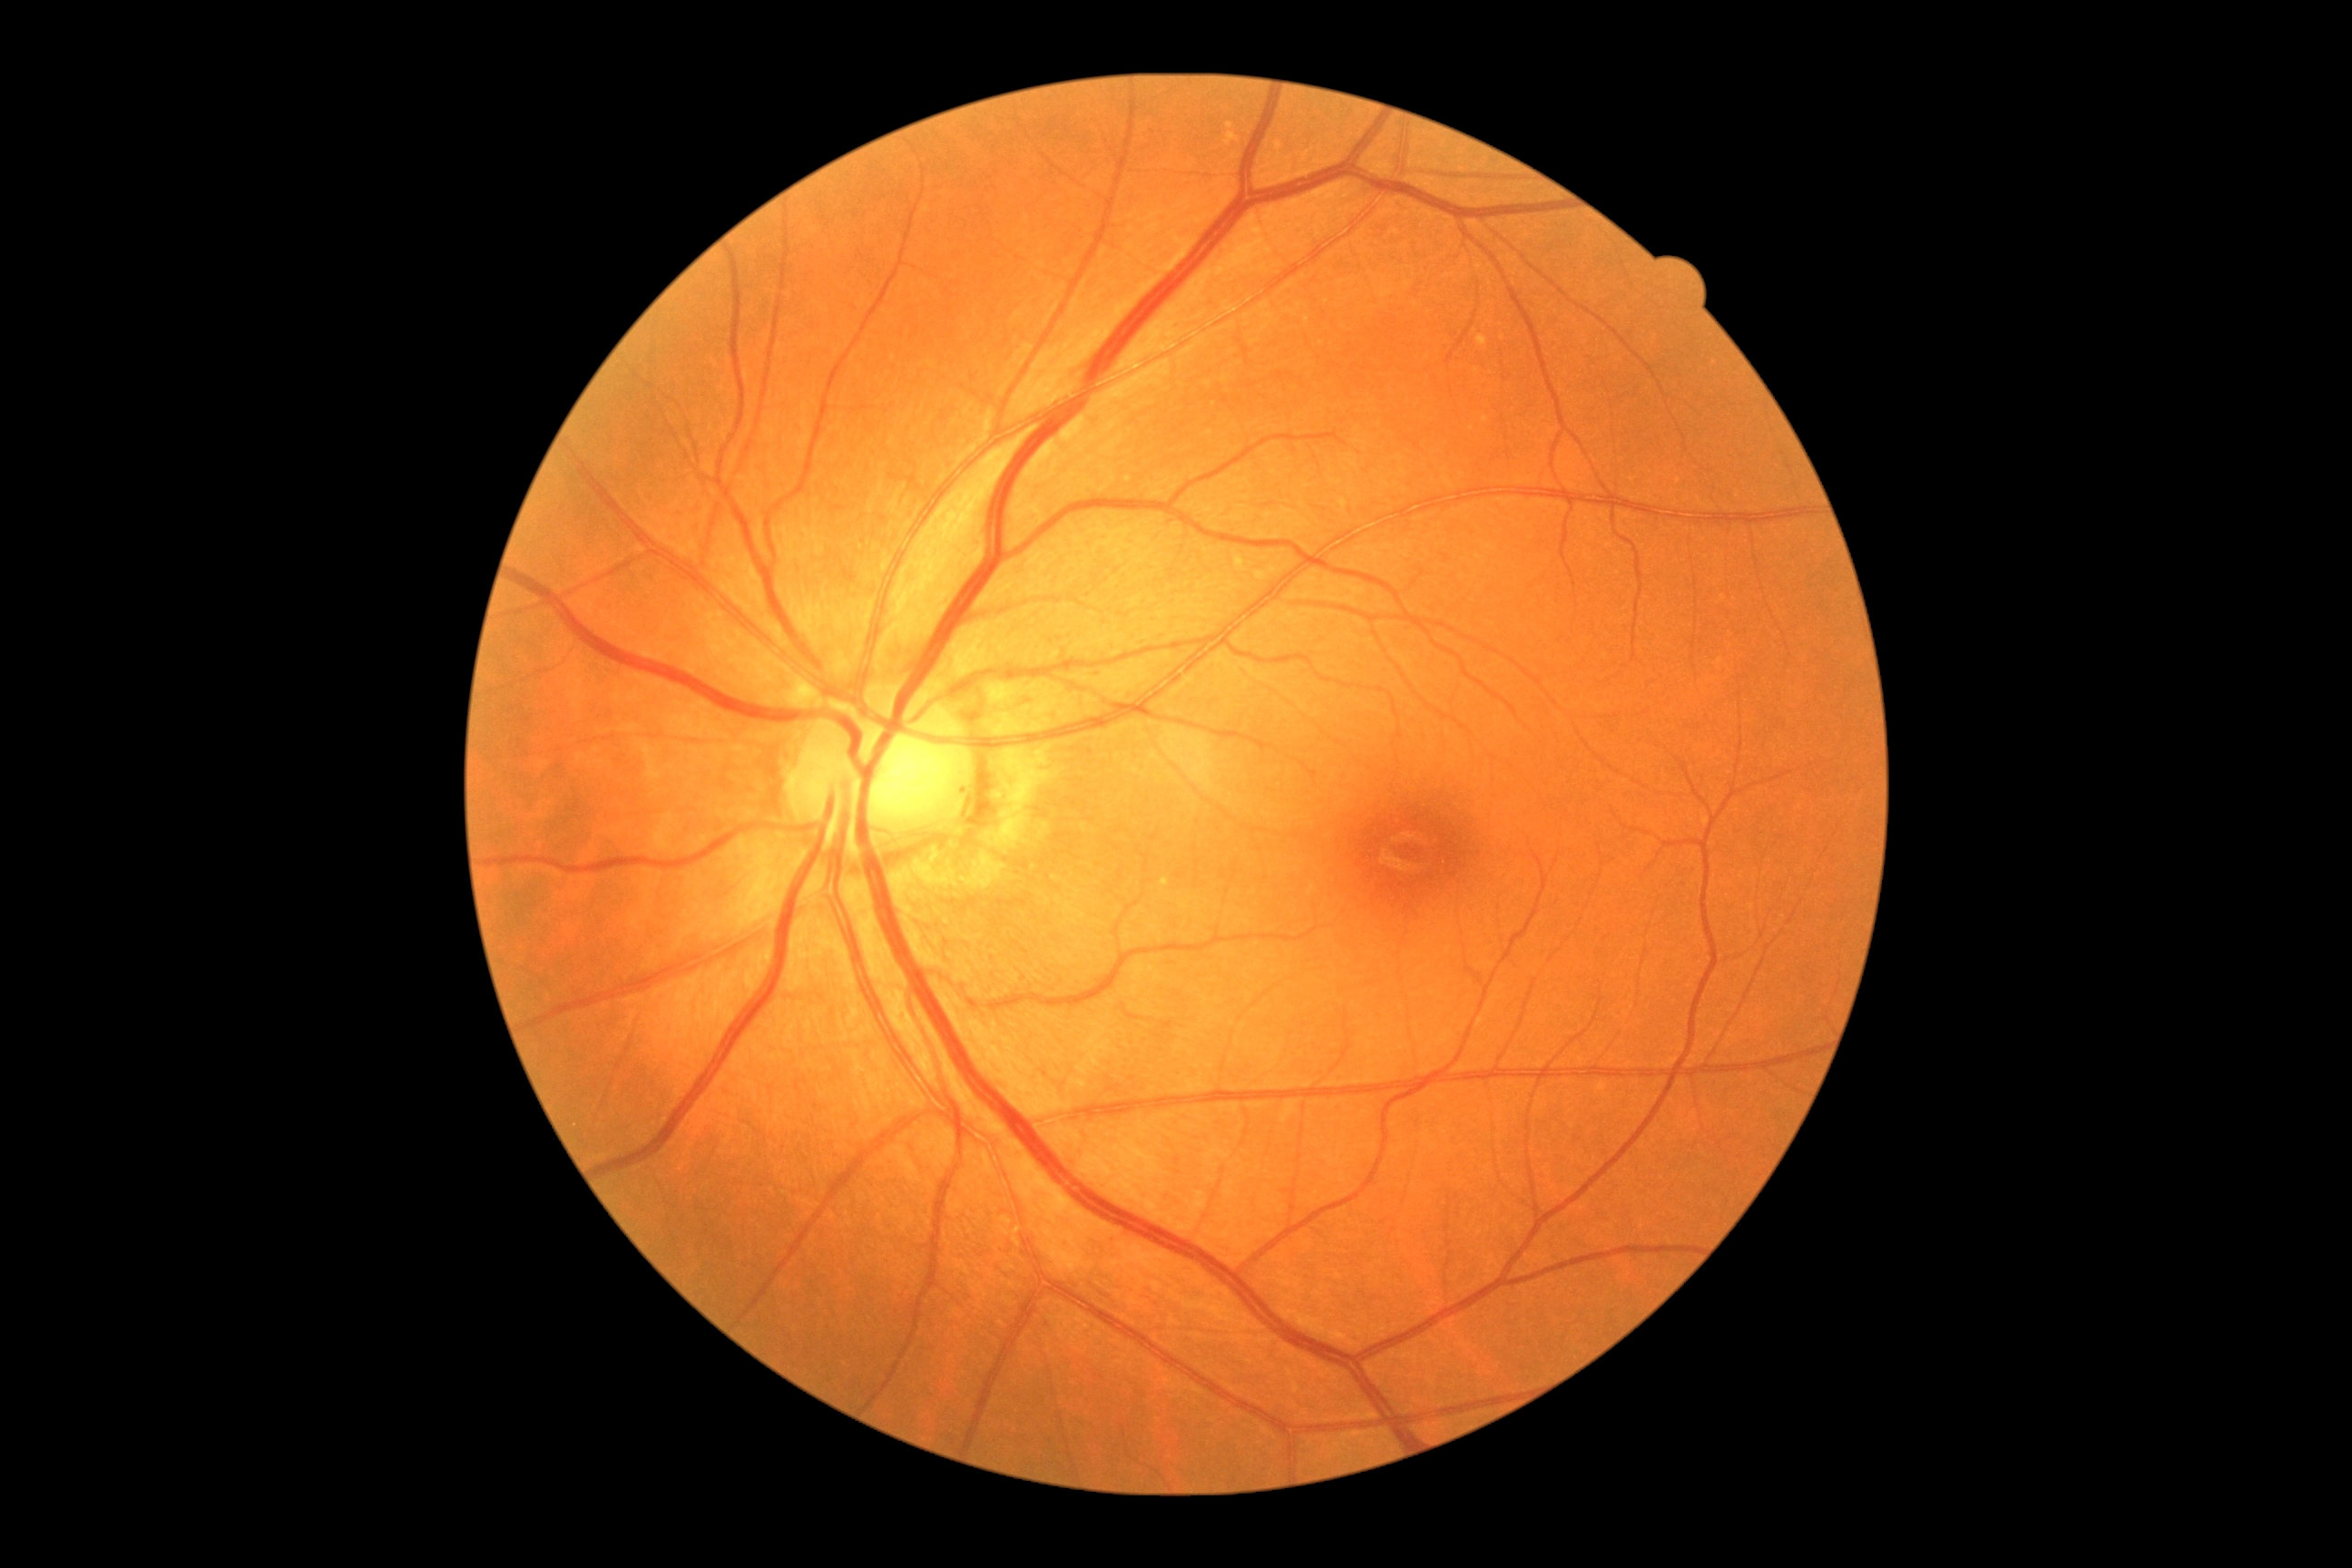

DR = 2.